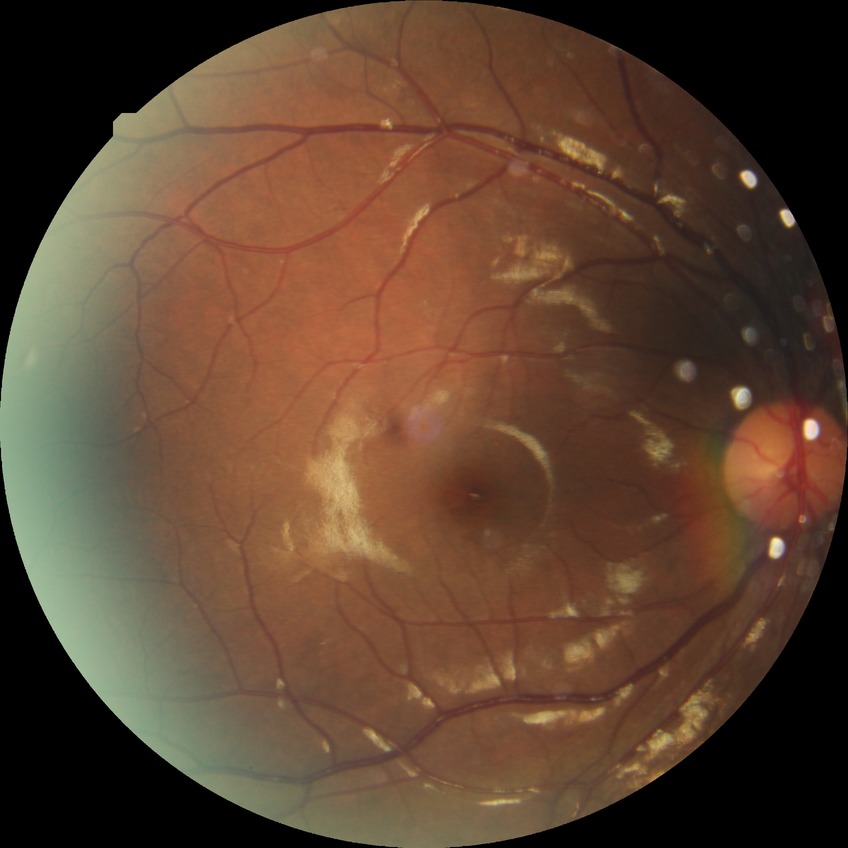
Diabetic retinopathy (DR): simple diabetic retinopathy (SDR).